Infant wide-field fundus photograph · captured with the Phoenix ICON (100° field of view) — 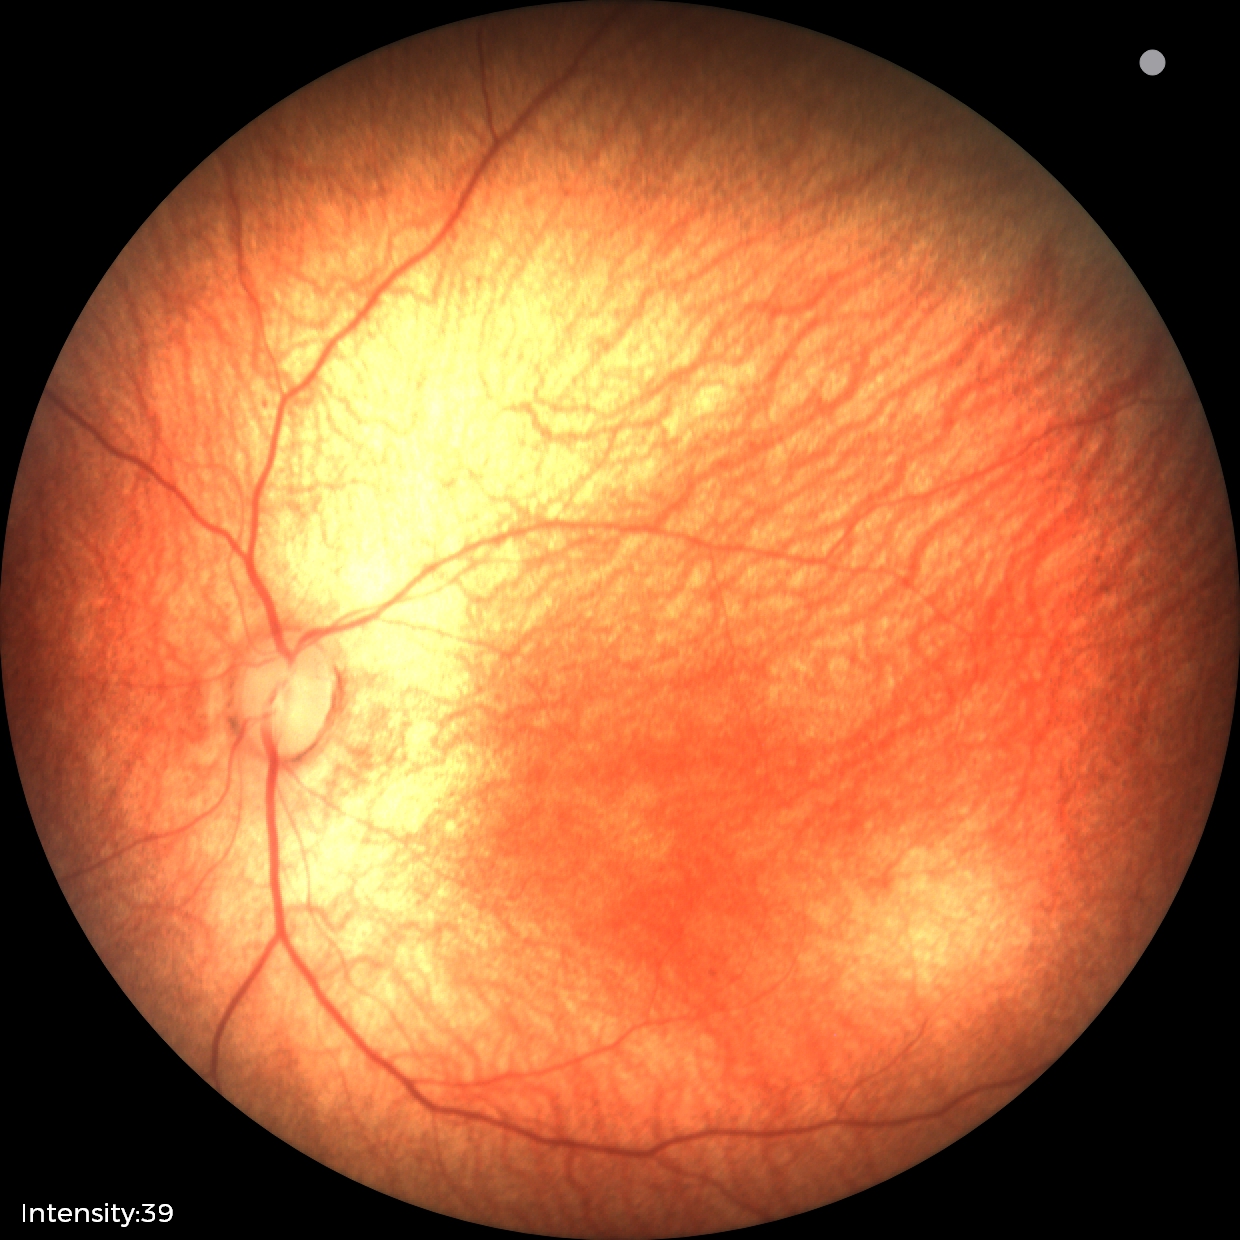

Physiological retinal appearance for postconceptual age.